CFP — 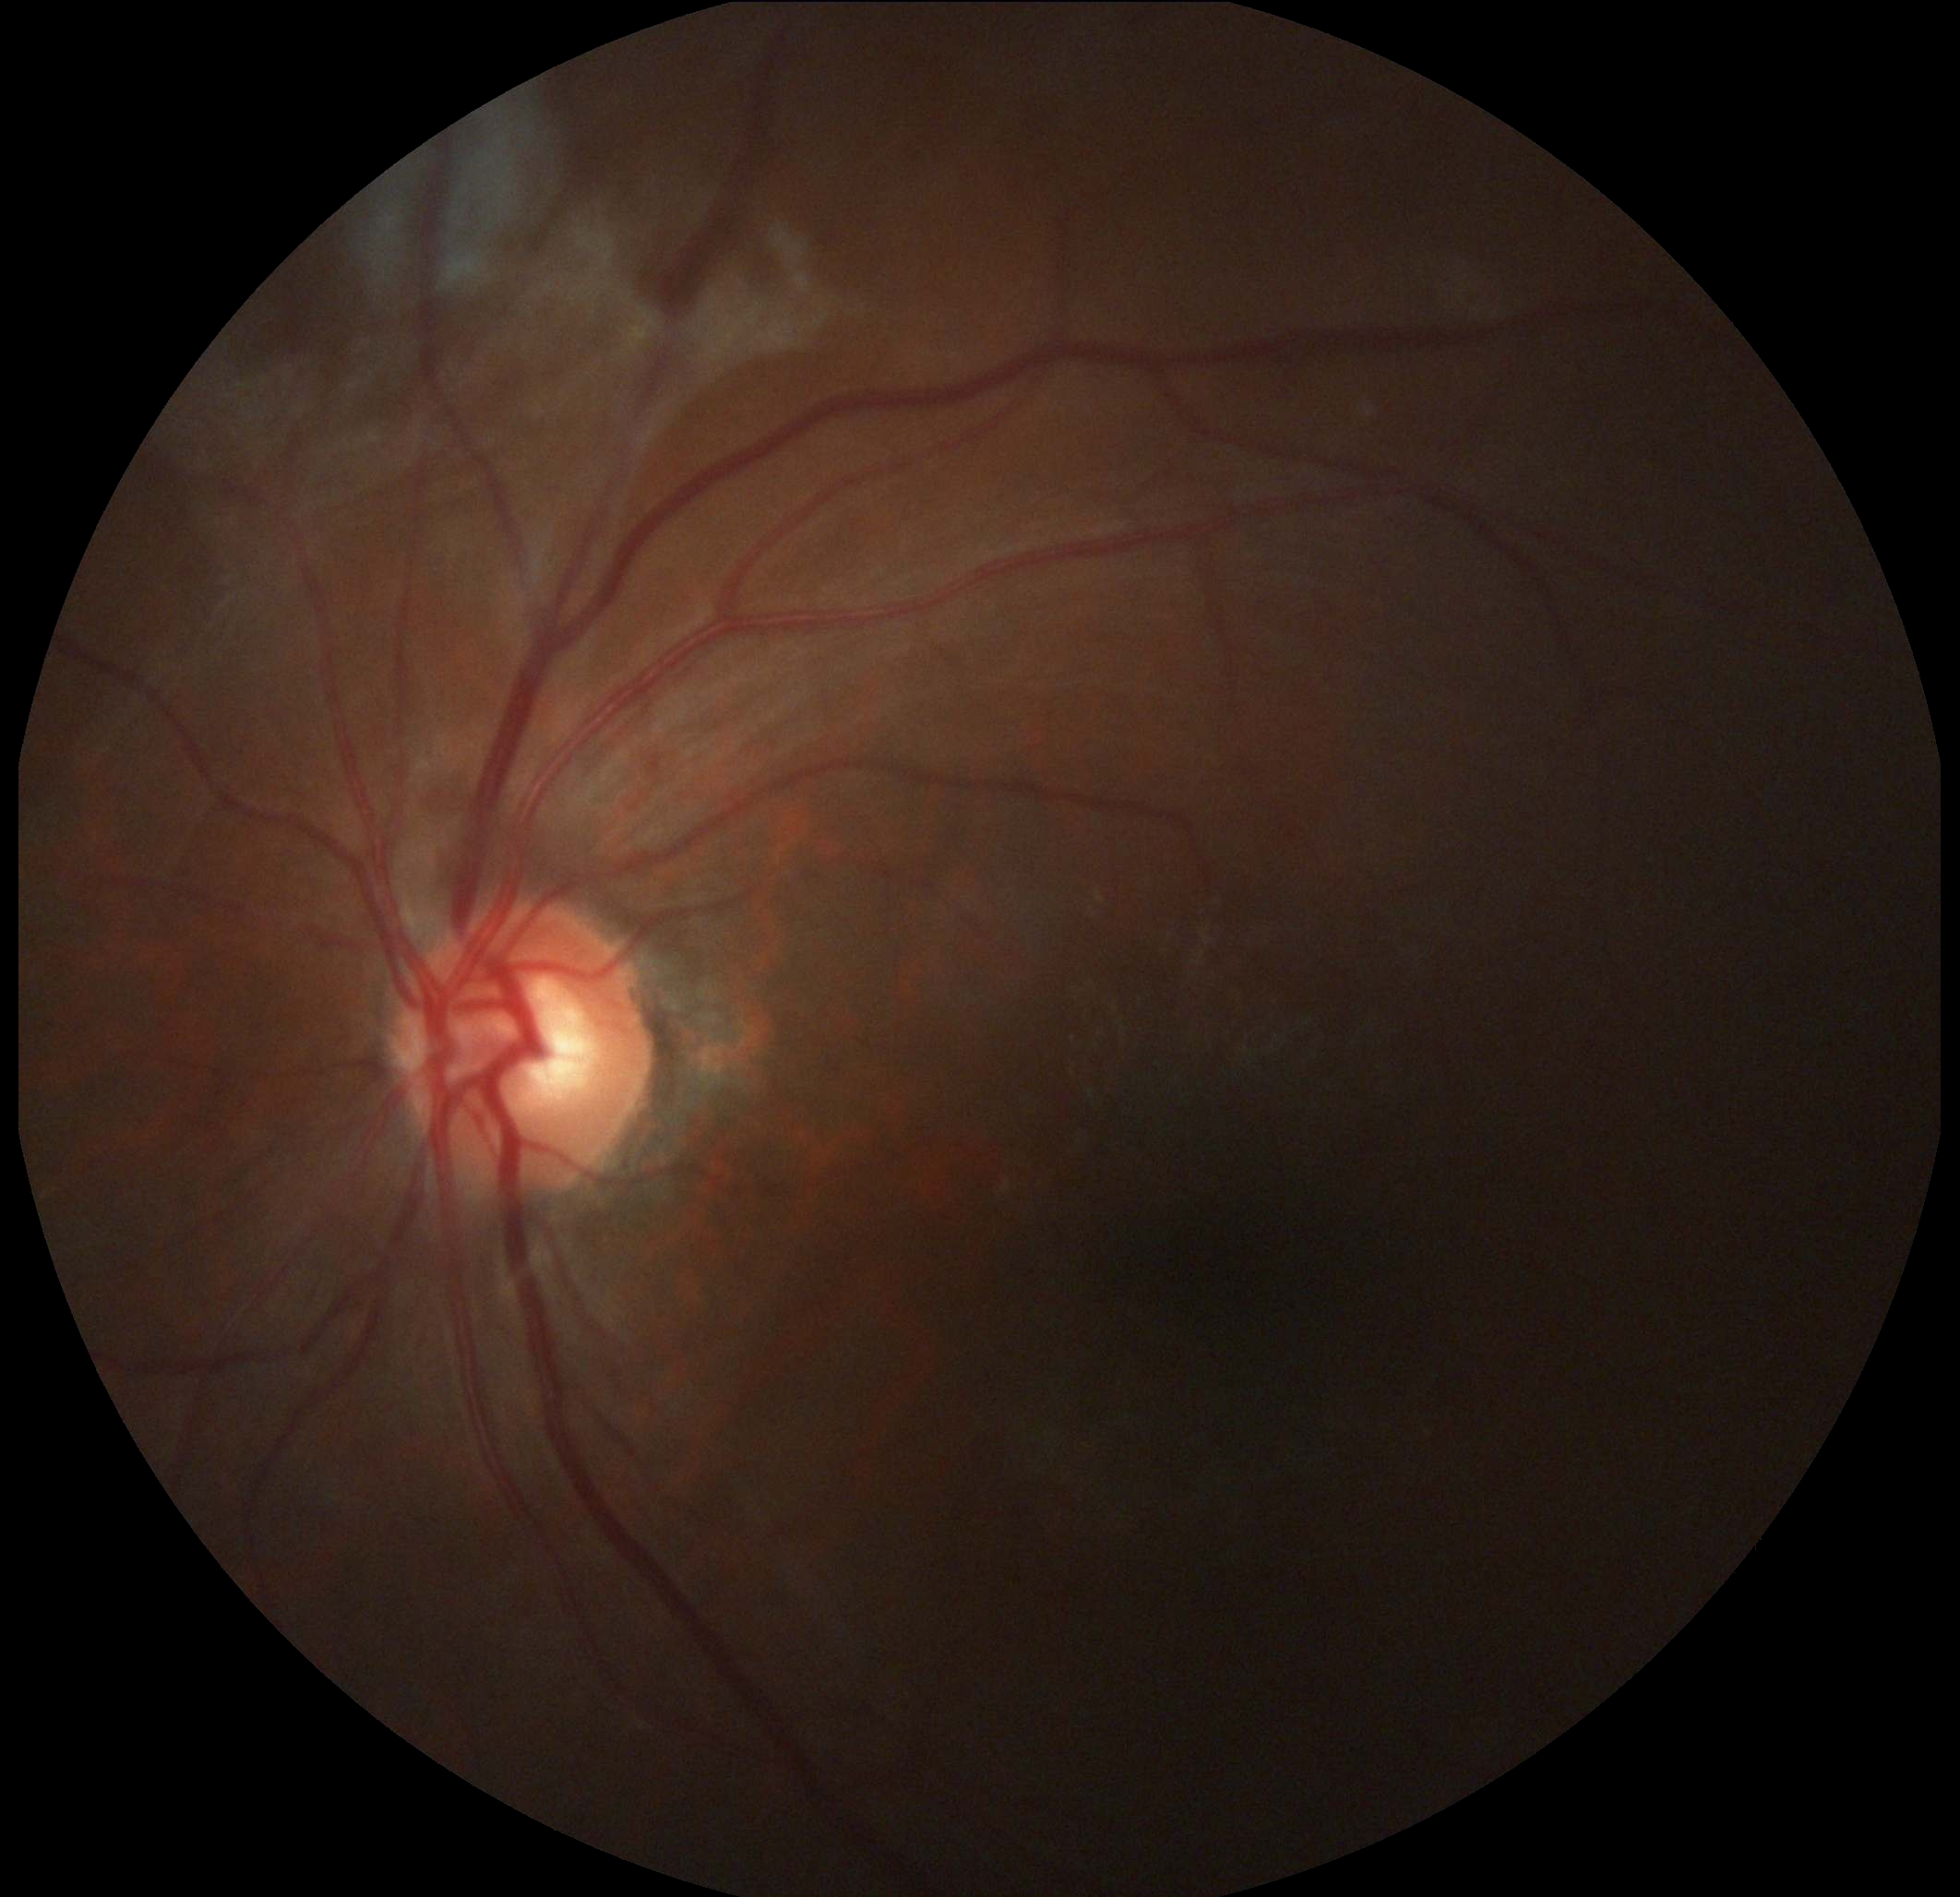 DR stage is proliferative diabetic retinopathy (grade 4).